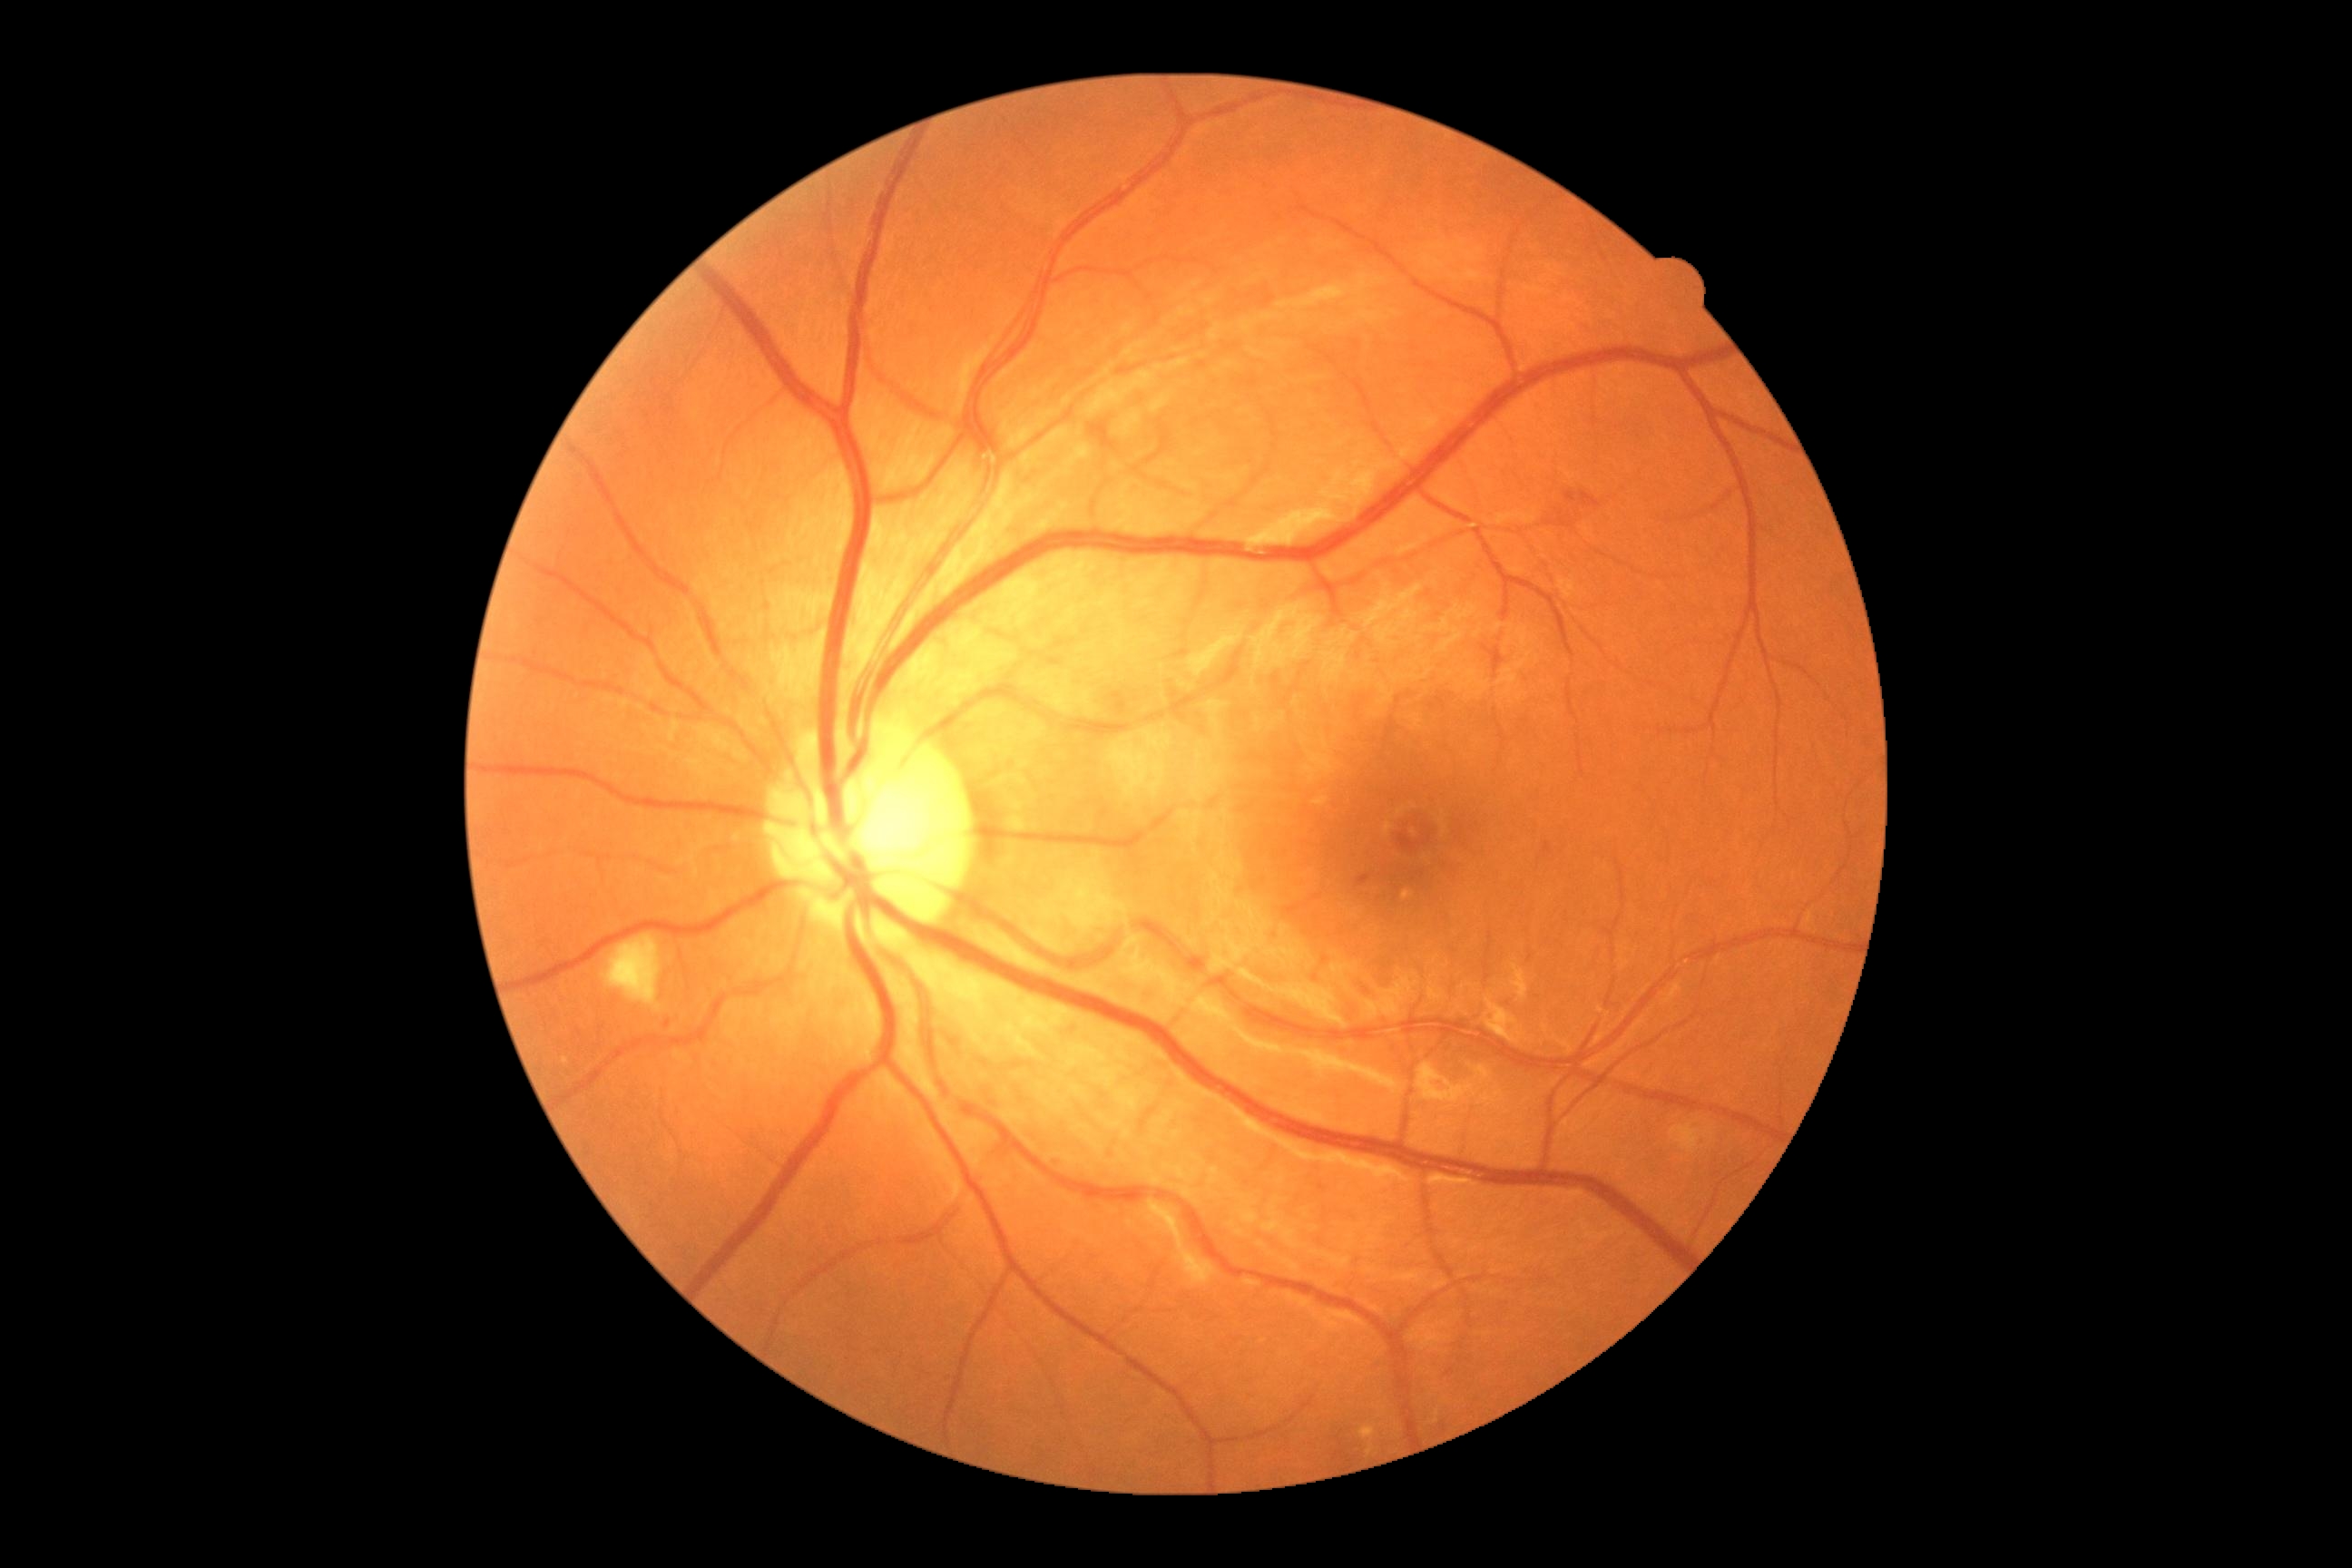
Annotations:
* DR class: non-proliferative diabetic retinopathy
* diabetic retinopathy grade: moderate non-proliferative diabetic retinopathy (2)